Pediatric wide-field fundus photograph · 640x480:
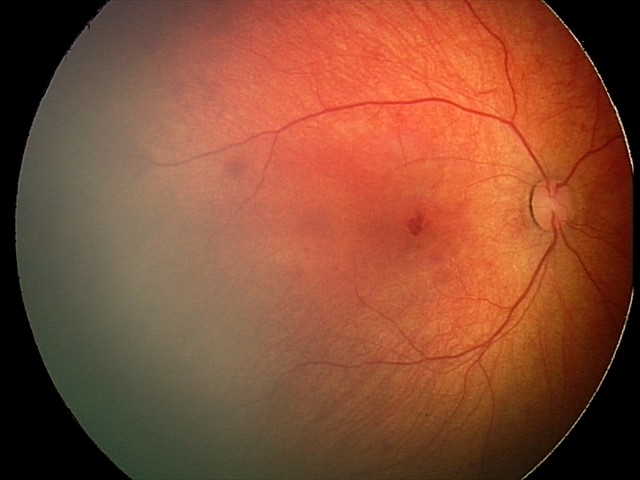 Screening diagnosis: retinal hemorrhages.